Graded on the modified Davis scale: 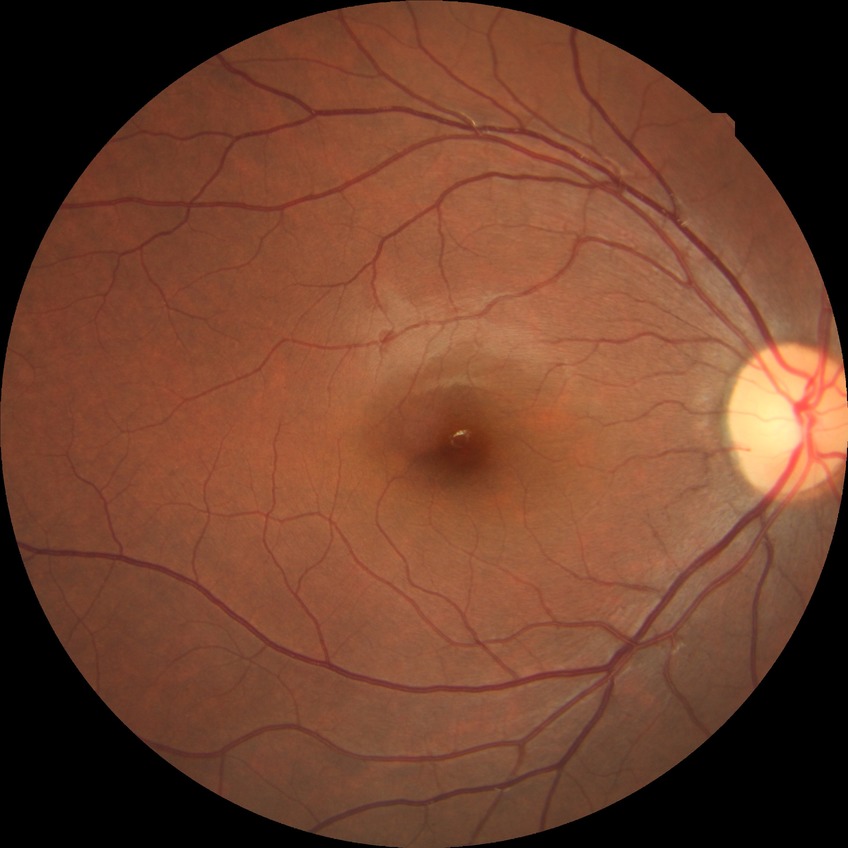 Diabetic retinopathy grade is no diabetic retinopathy.